Camera: Natus RetCam Envision (130° FOV); pediatric wide-field fundus photograph; 1440x1080px.
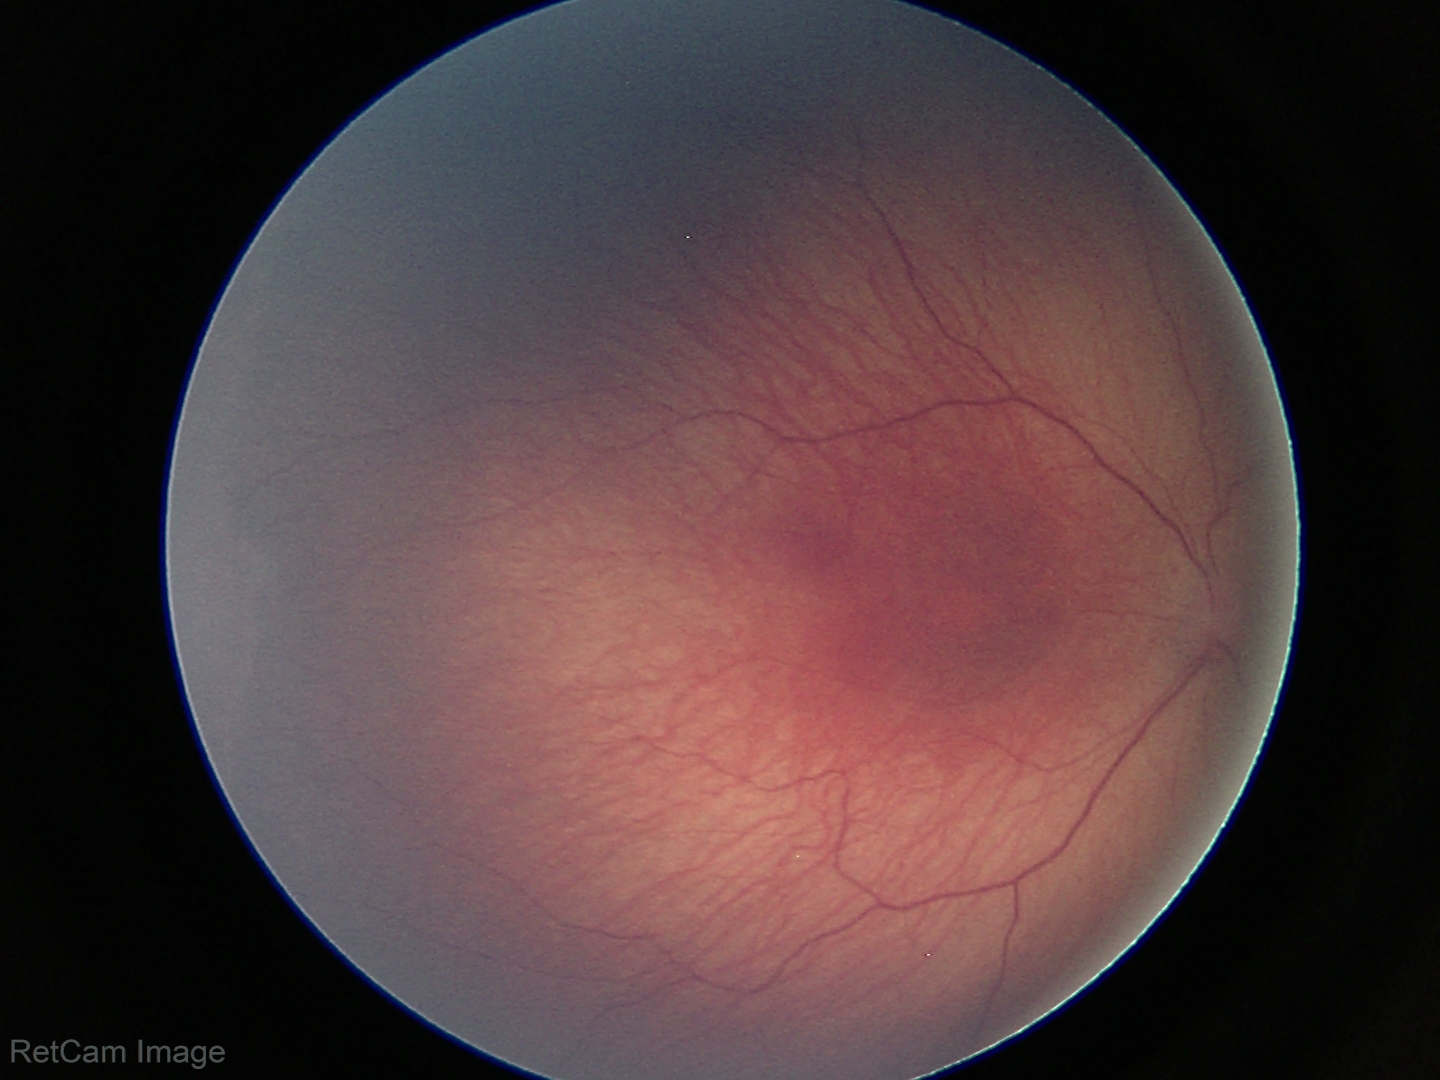 Screening examination consistent with ROP stage 1.
Plus disease absent.